Infant wide-field fundus photograph.
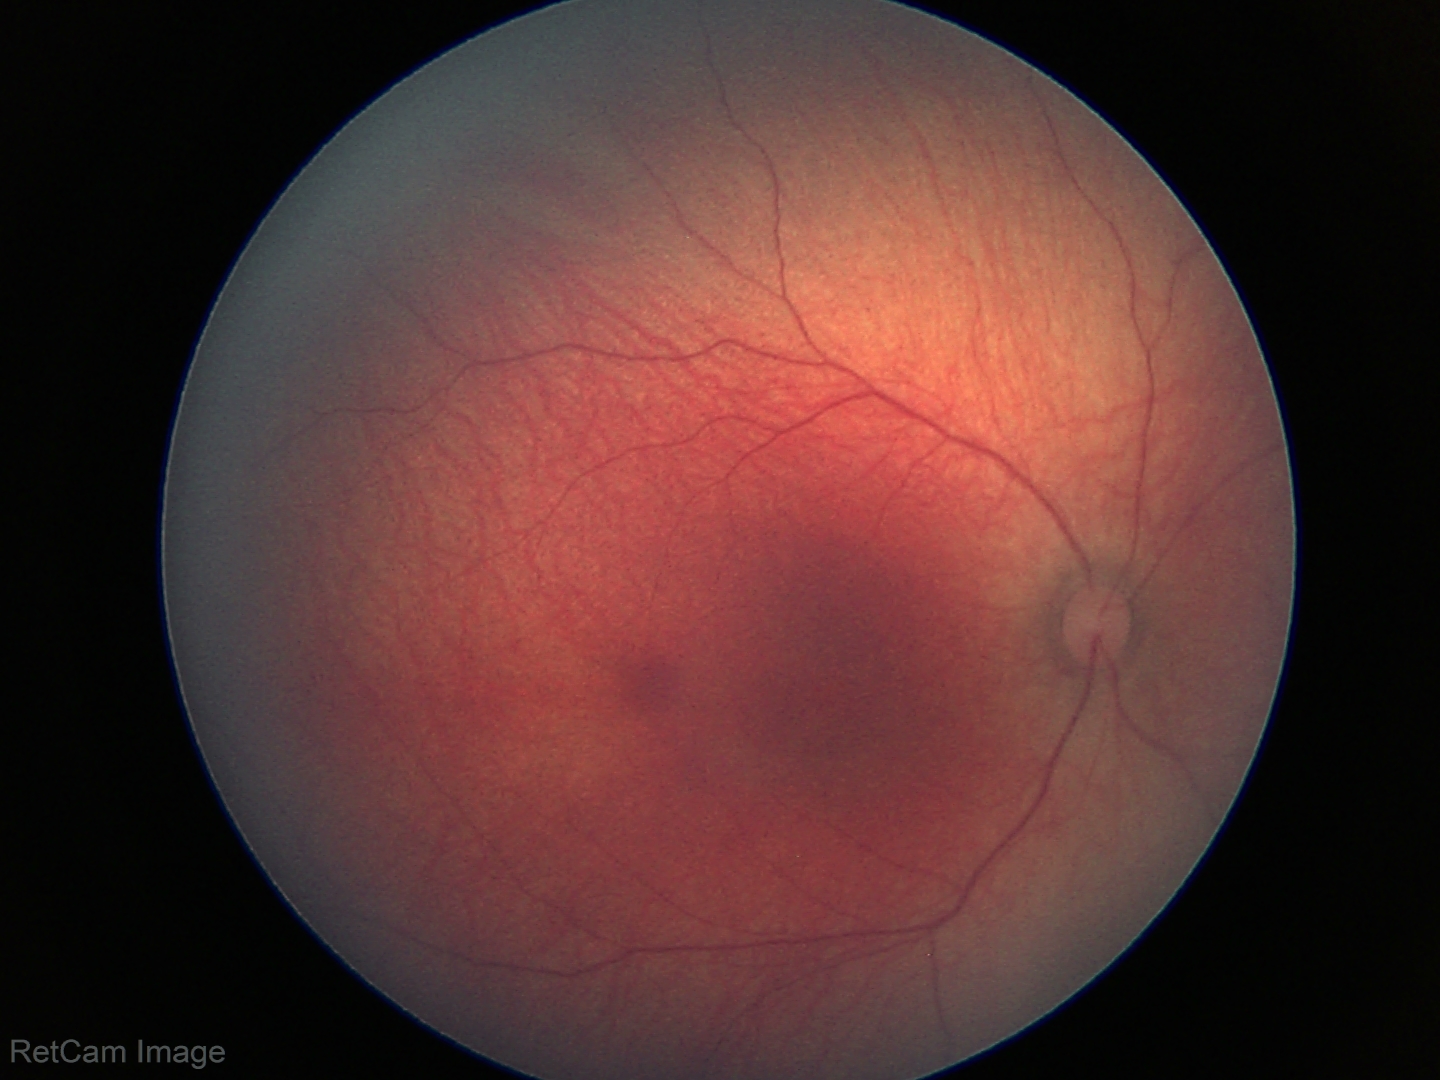
Physiological retinal appearance for postconceptual age.